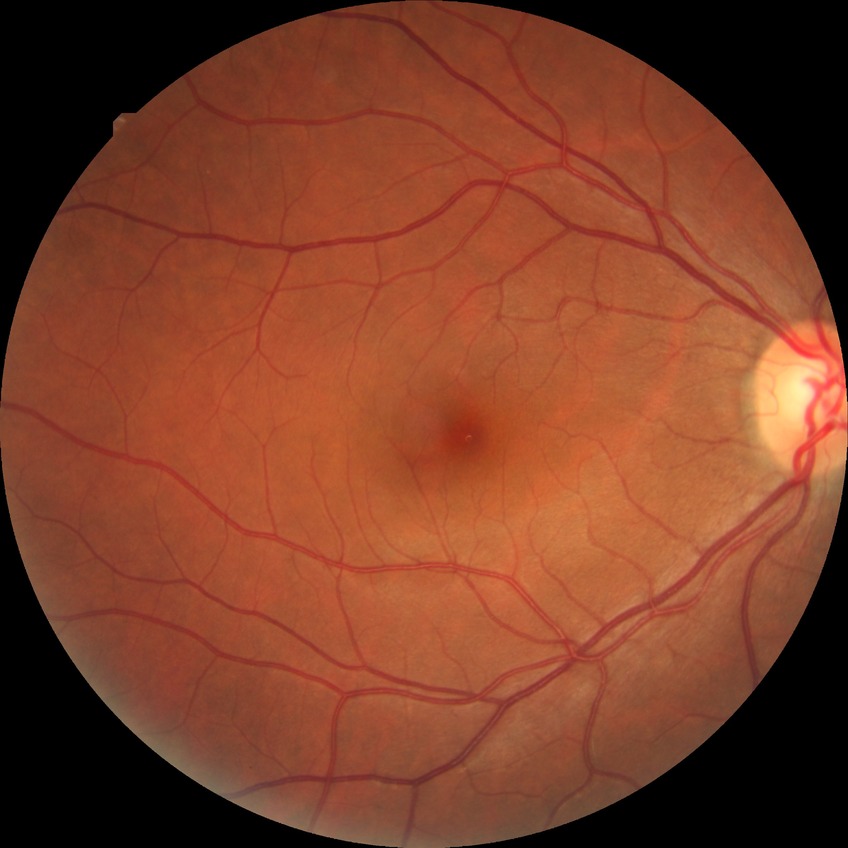 diabetic retinopathy severity = no diabetic retinopathy.